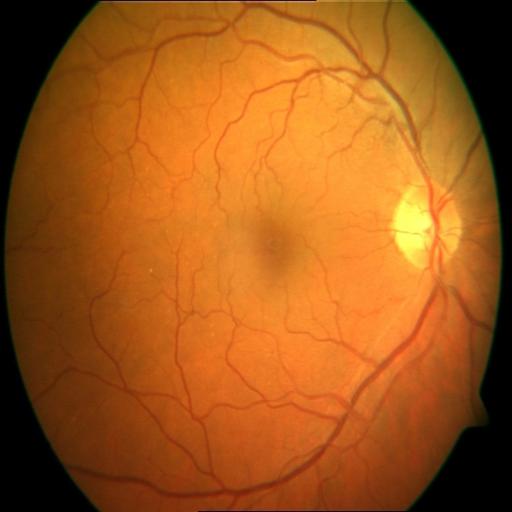 Findings: cystoid macular edema (CME).